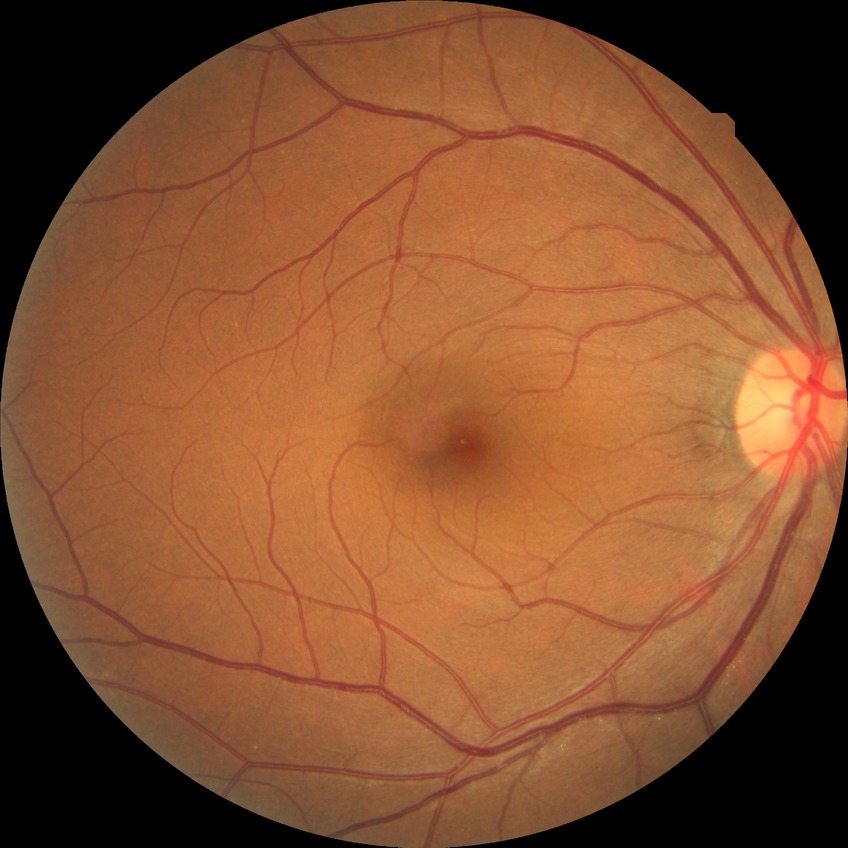
Retinopathy stage: no diabetic retinopathy.